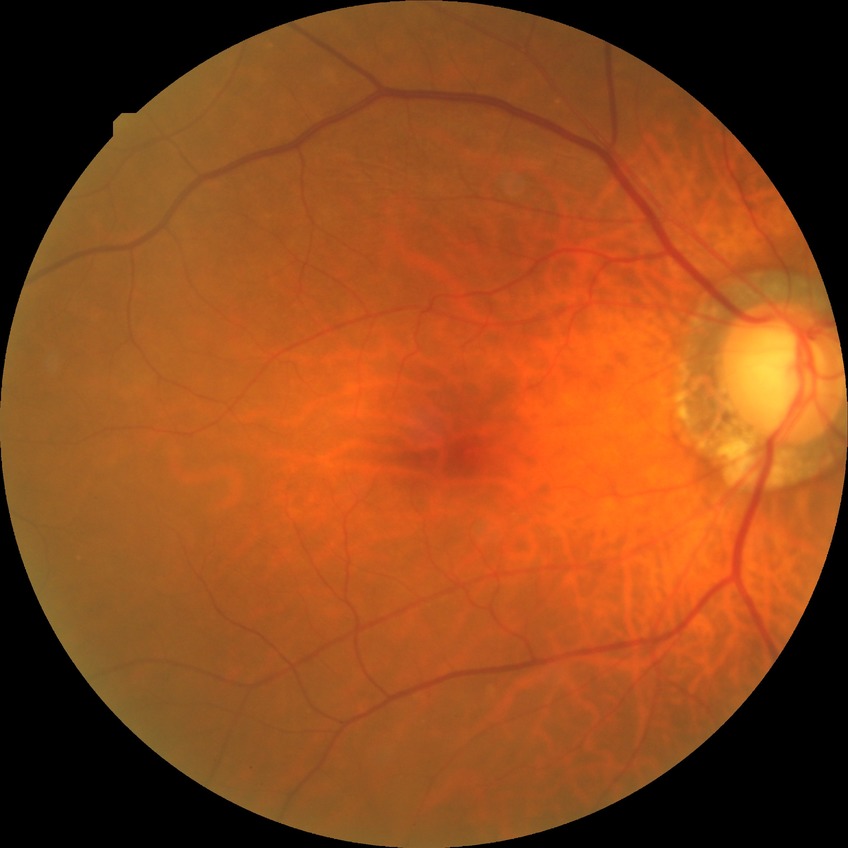

retinopathy stage: no diabetic retinopathy.